CFP
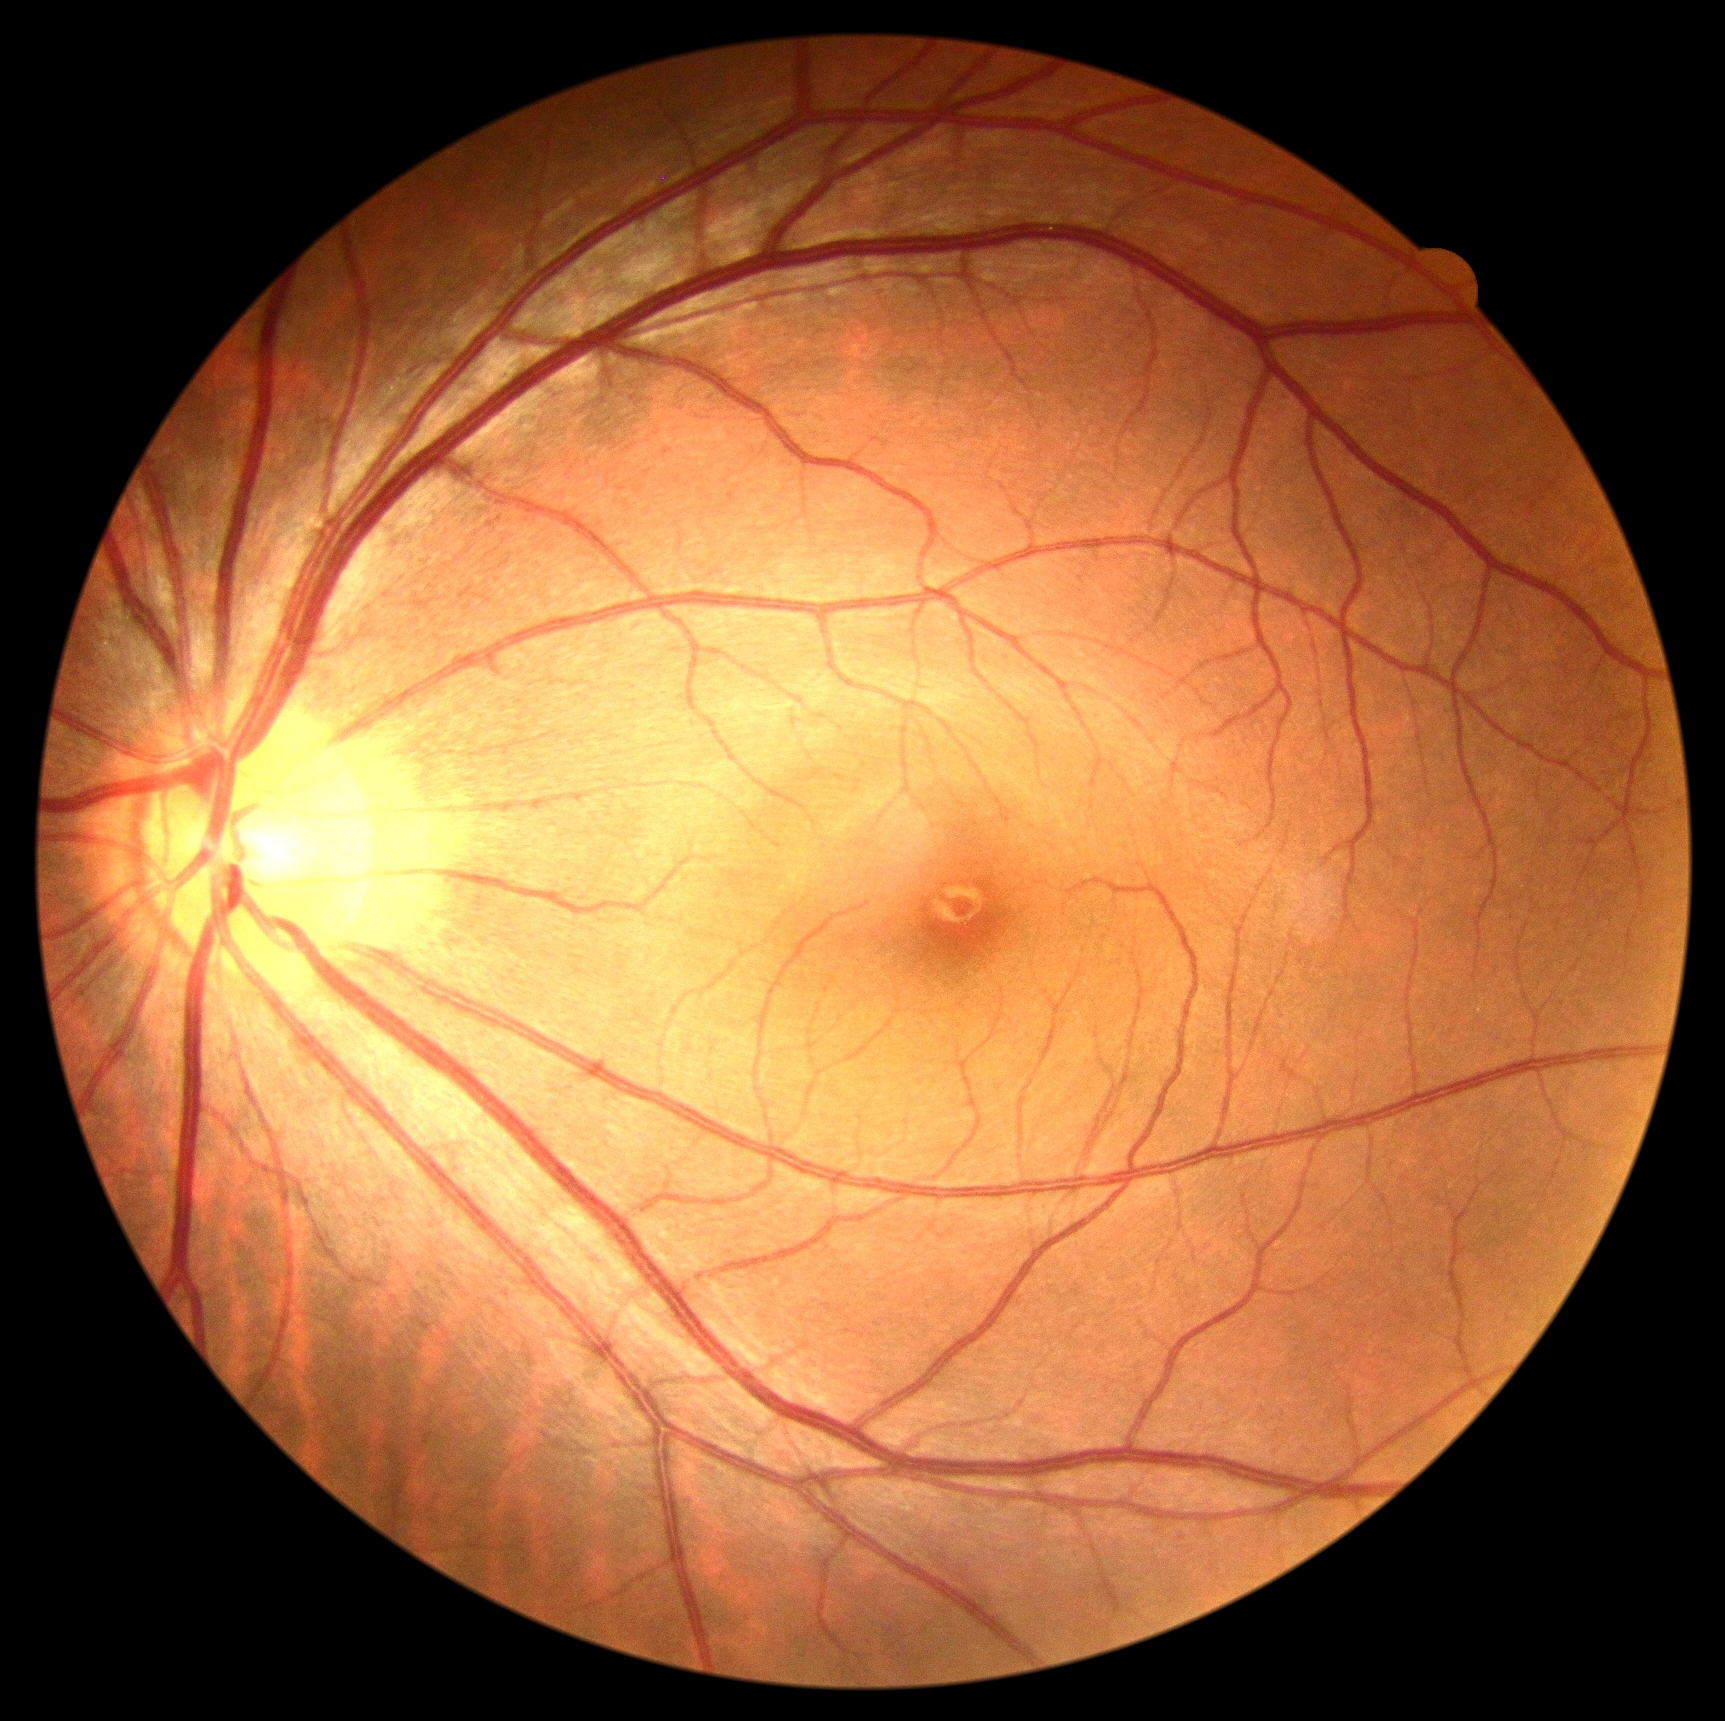 DR grade=0.